Pediatric retinal photograph (wide-field):
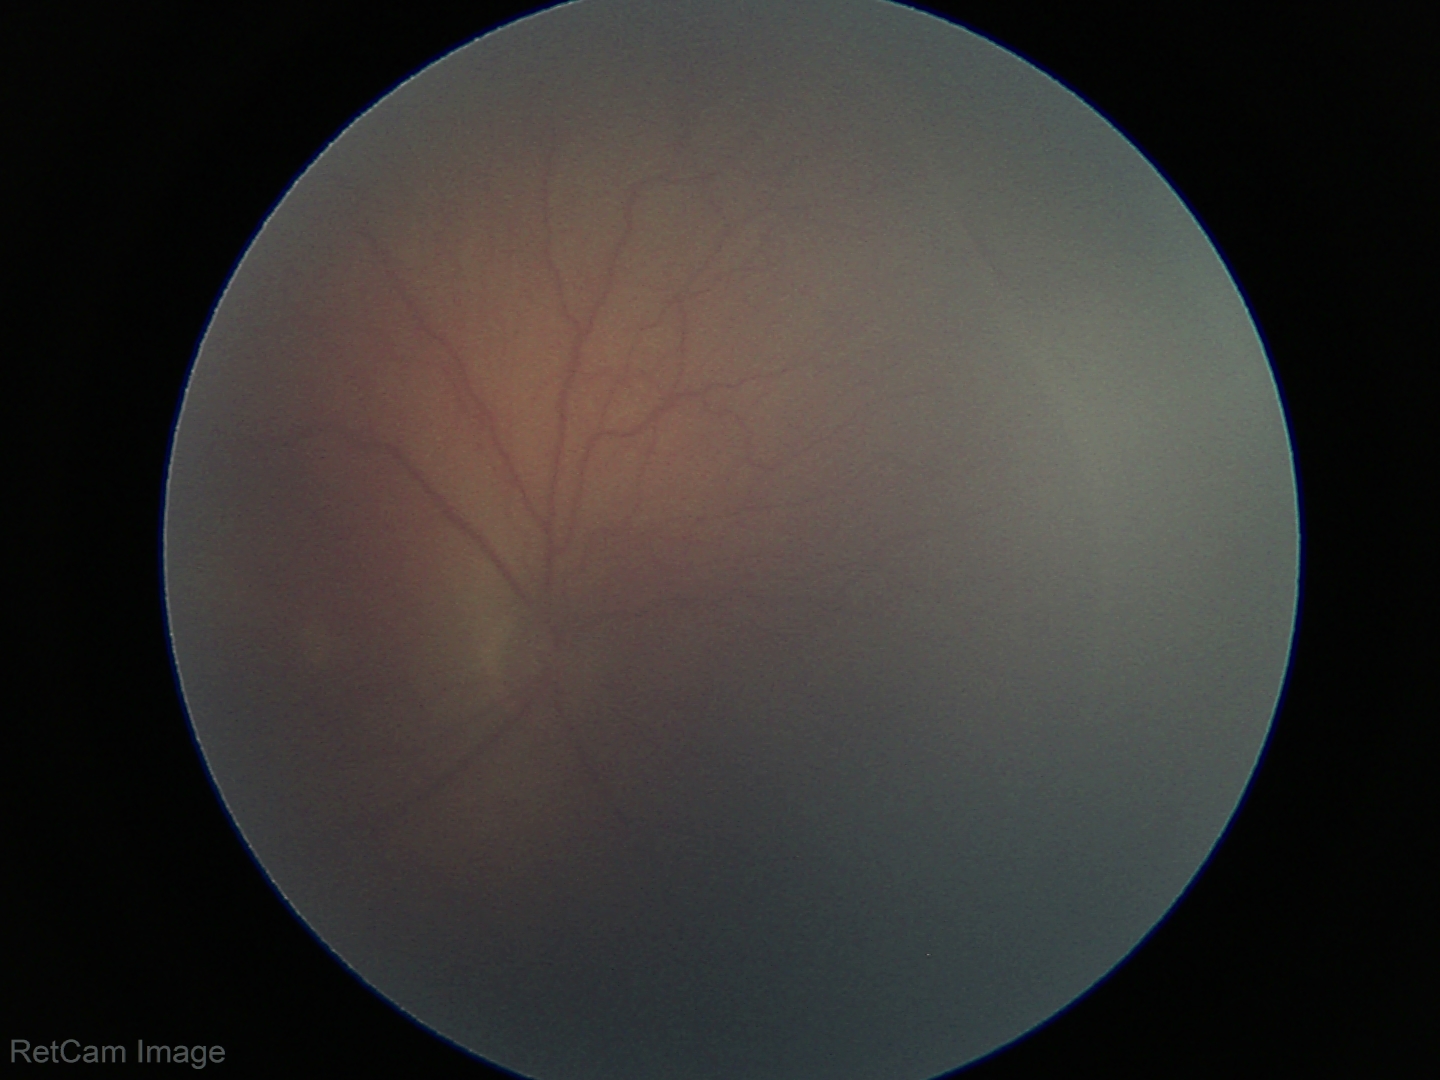 No plus disease.
Diagnosis from this screening exam: retinopathy of prematurity stage 2.